Fundus photo: 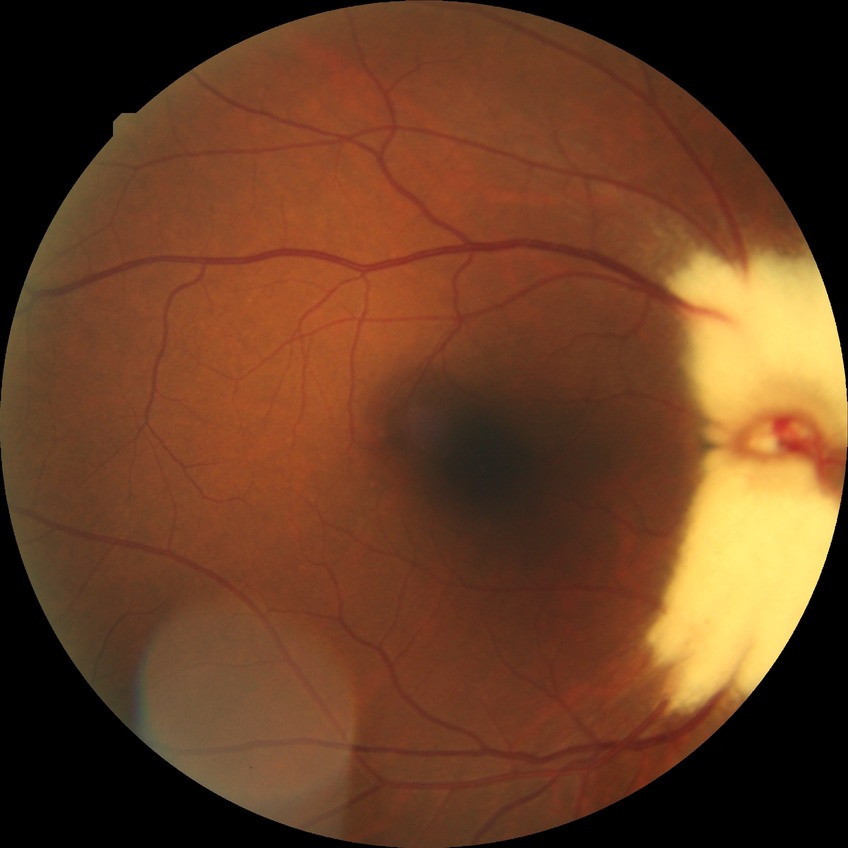
Davis grade: NDR, DR impression: negative for DR.